Modified Davis classification — 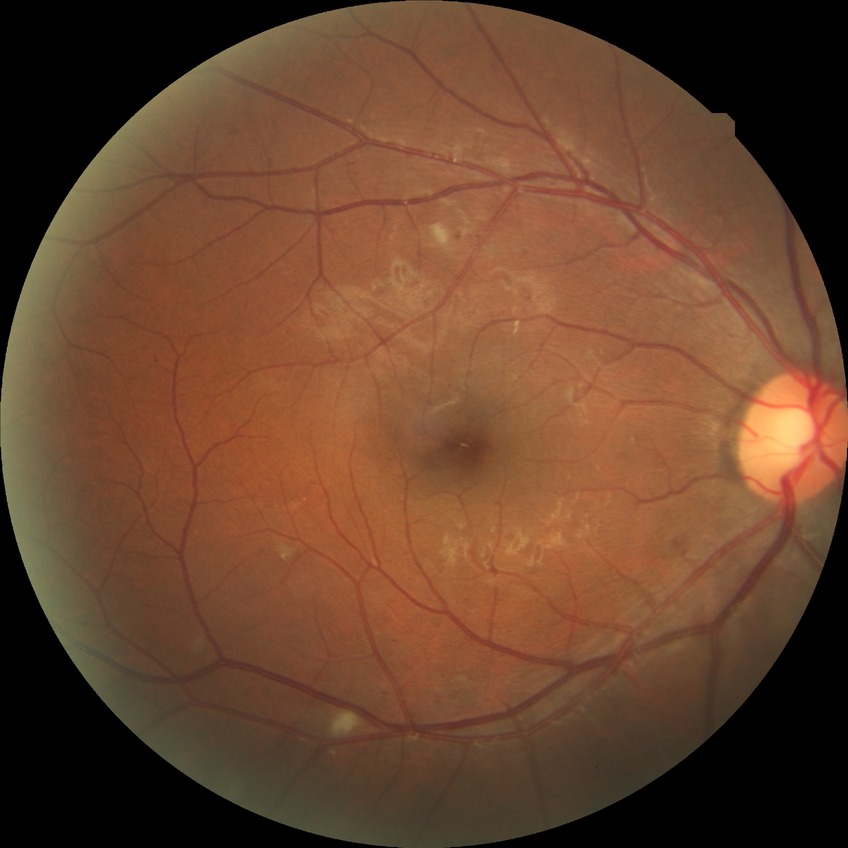 Annotations:
* DR class — non-proliferative diabetic retinopathy
* diabetic retinopathy (DR) — PPDR (pre-proliferative diabetic retinopathy)